Pupil-dilated: 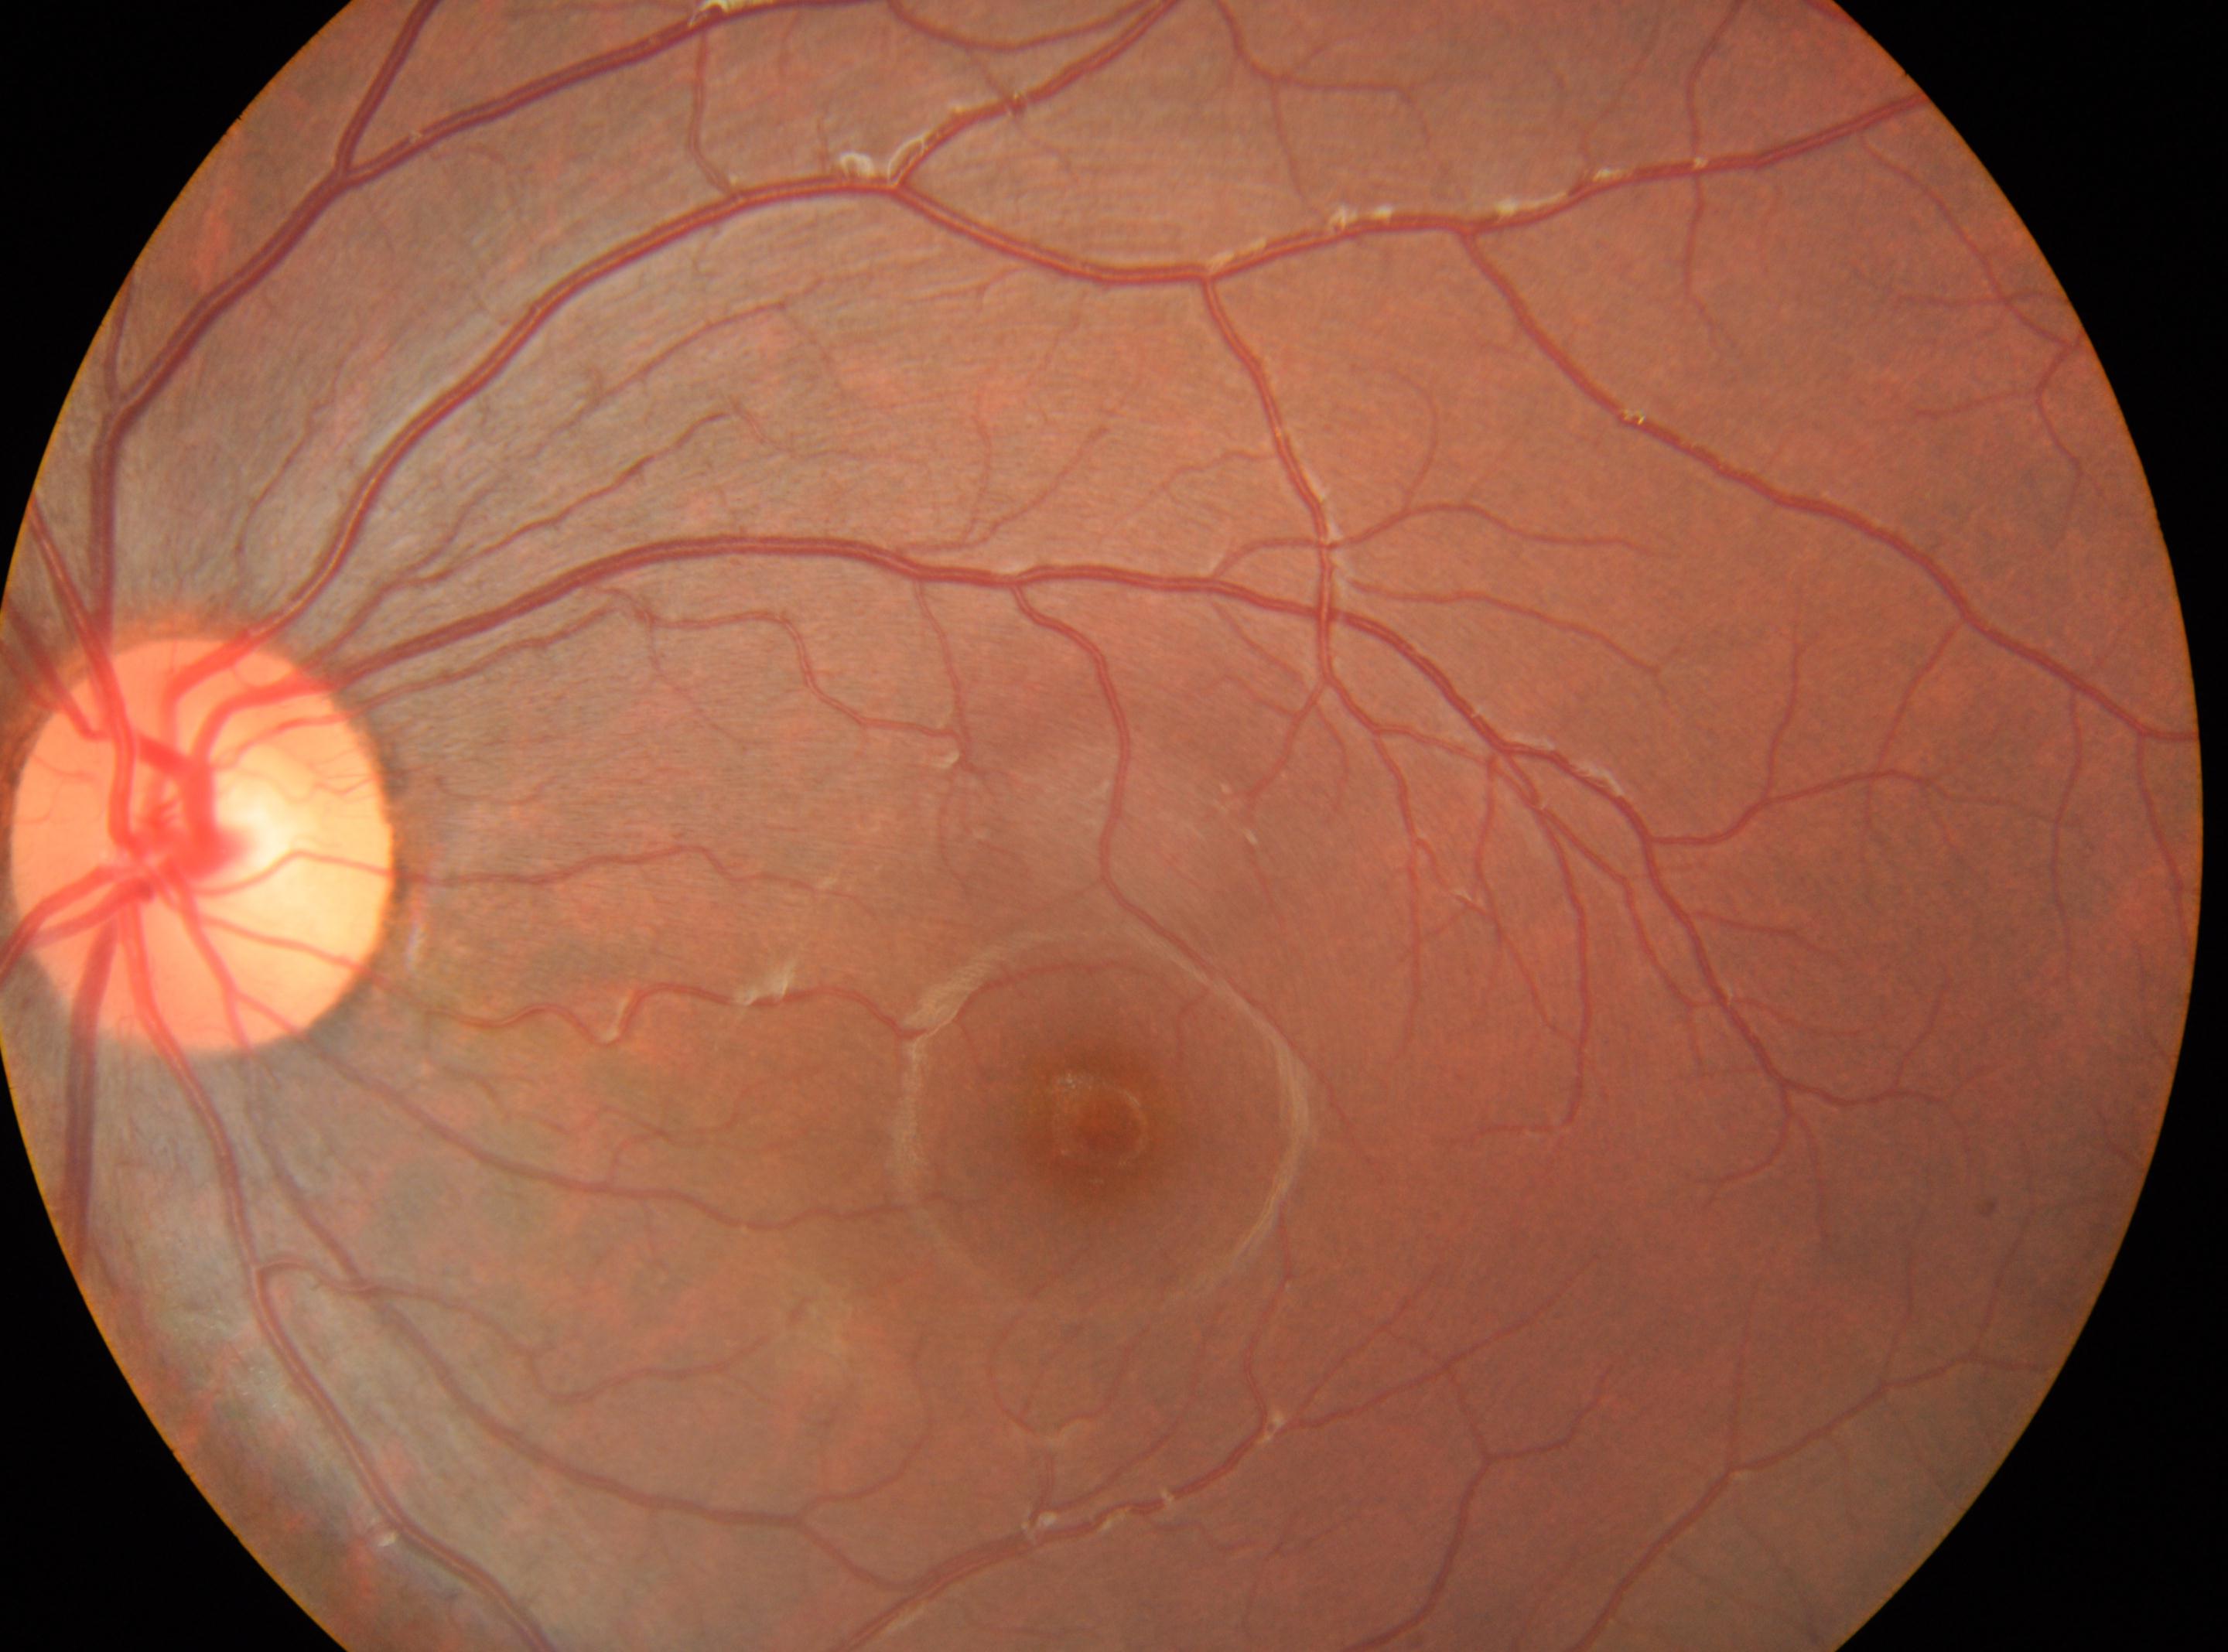 Optic disc: (x: 203, y: 845).
No DR findings.
Macula center: (x: 1105, y: 1126).
The image shows the OS.
Diabetic retinopathy (DR) is 0.